848 by 848 pixels. DR severity per modified Davis staging: 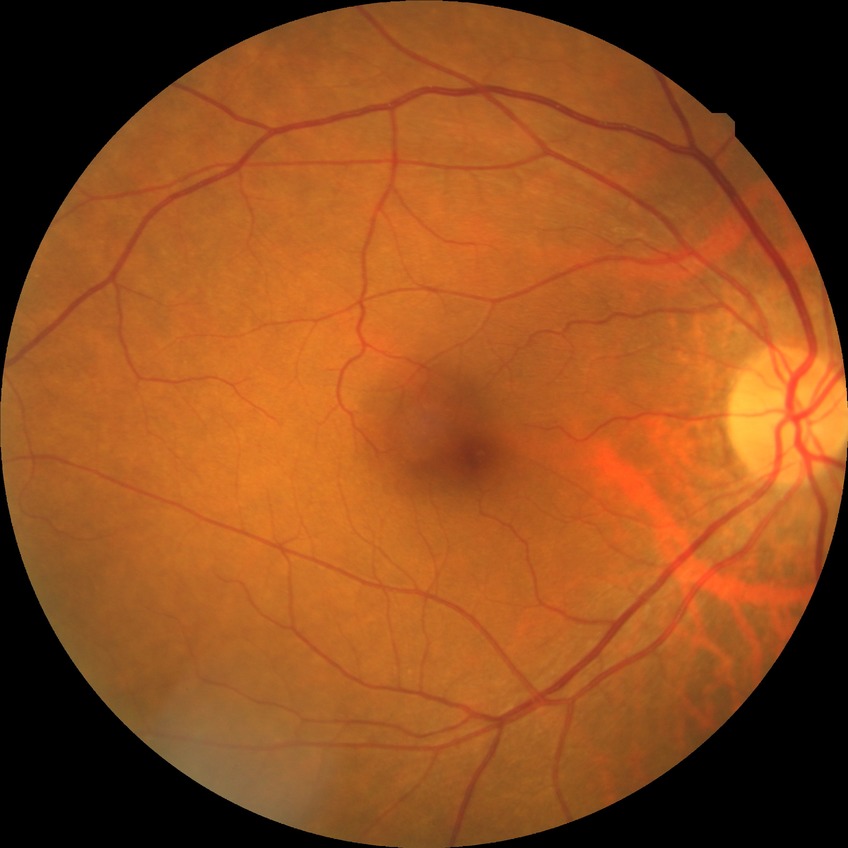
Diabetic retinopathy severity is no diabetic retinopathy.